Color fundus photograph
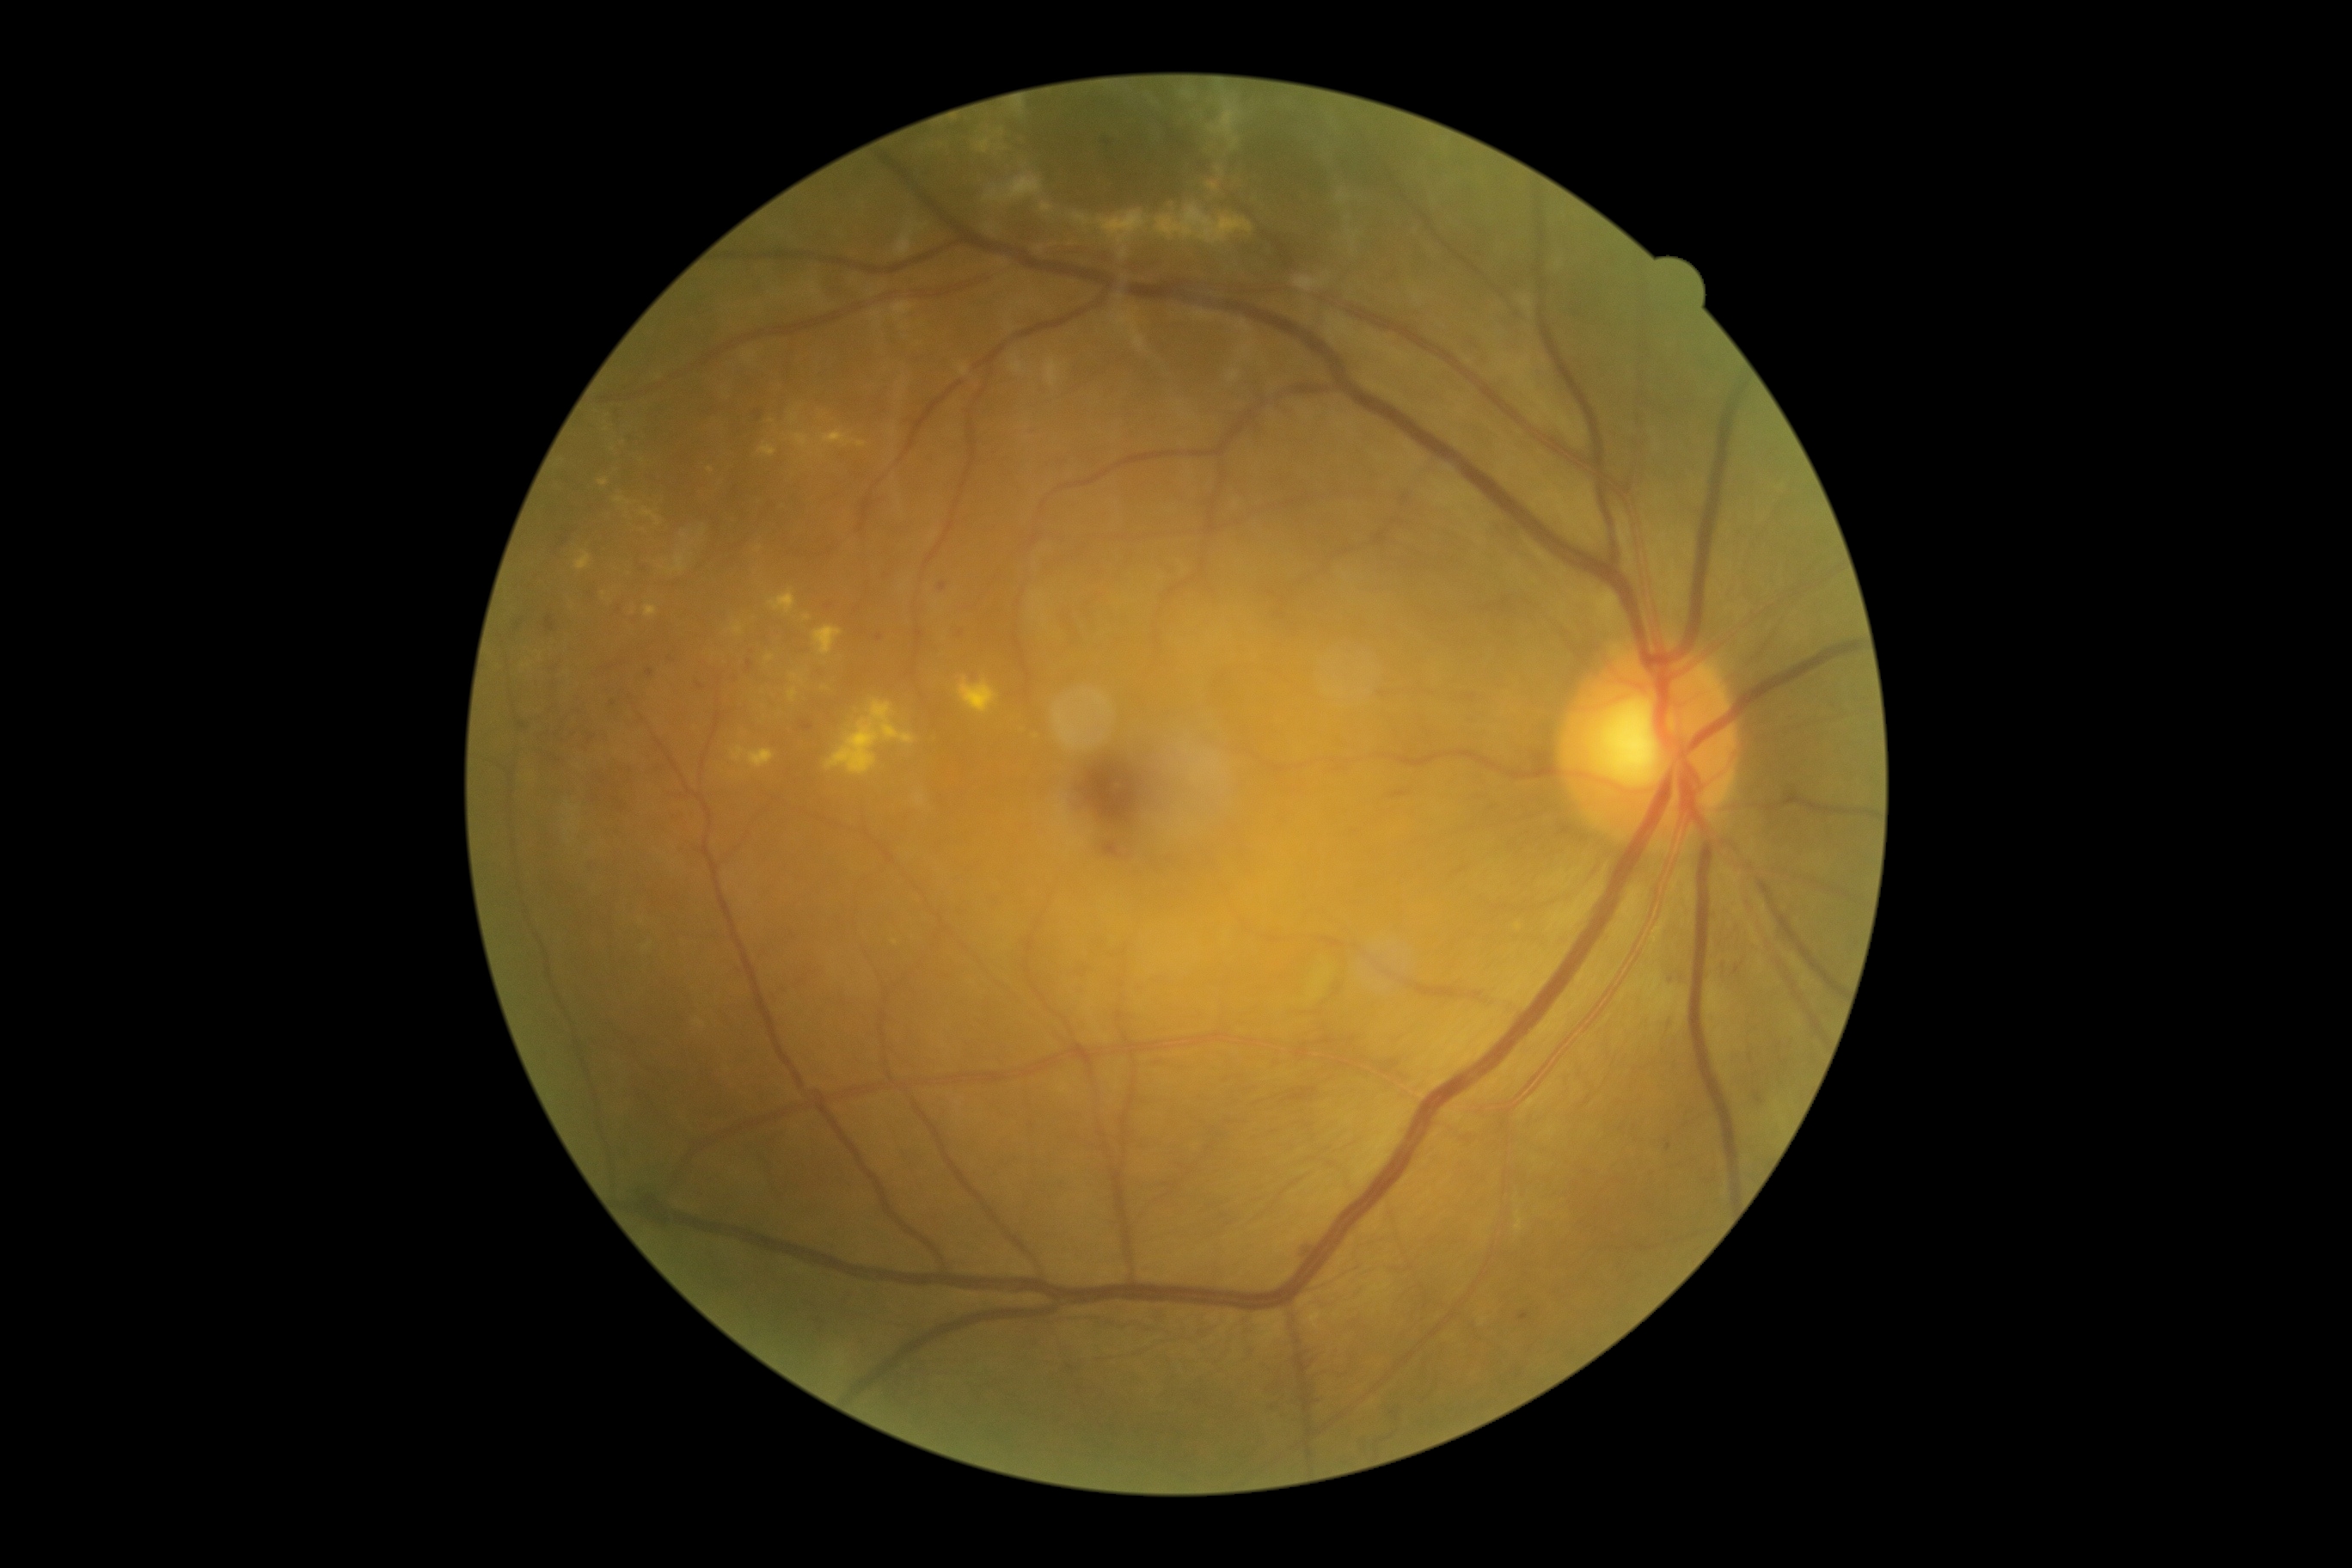 Diabetic retinopathy (DR) is 3.